RetCam wide-field infant fundus image — 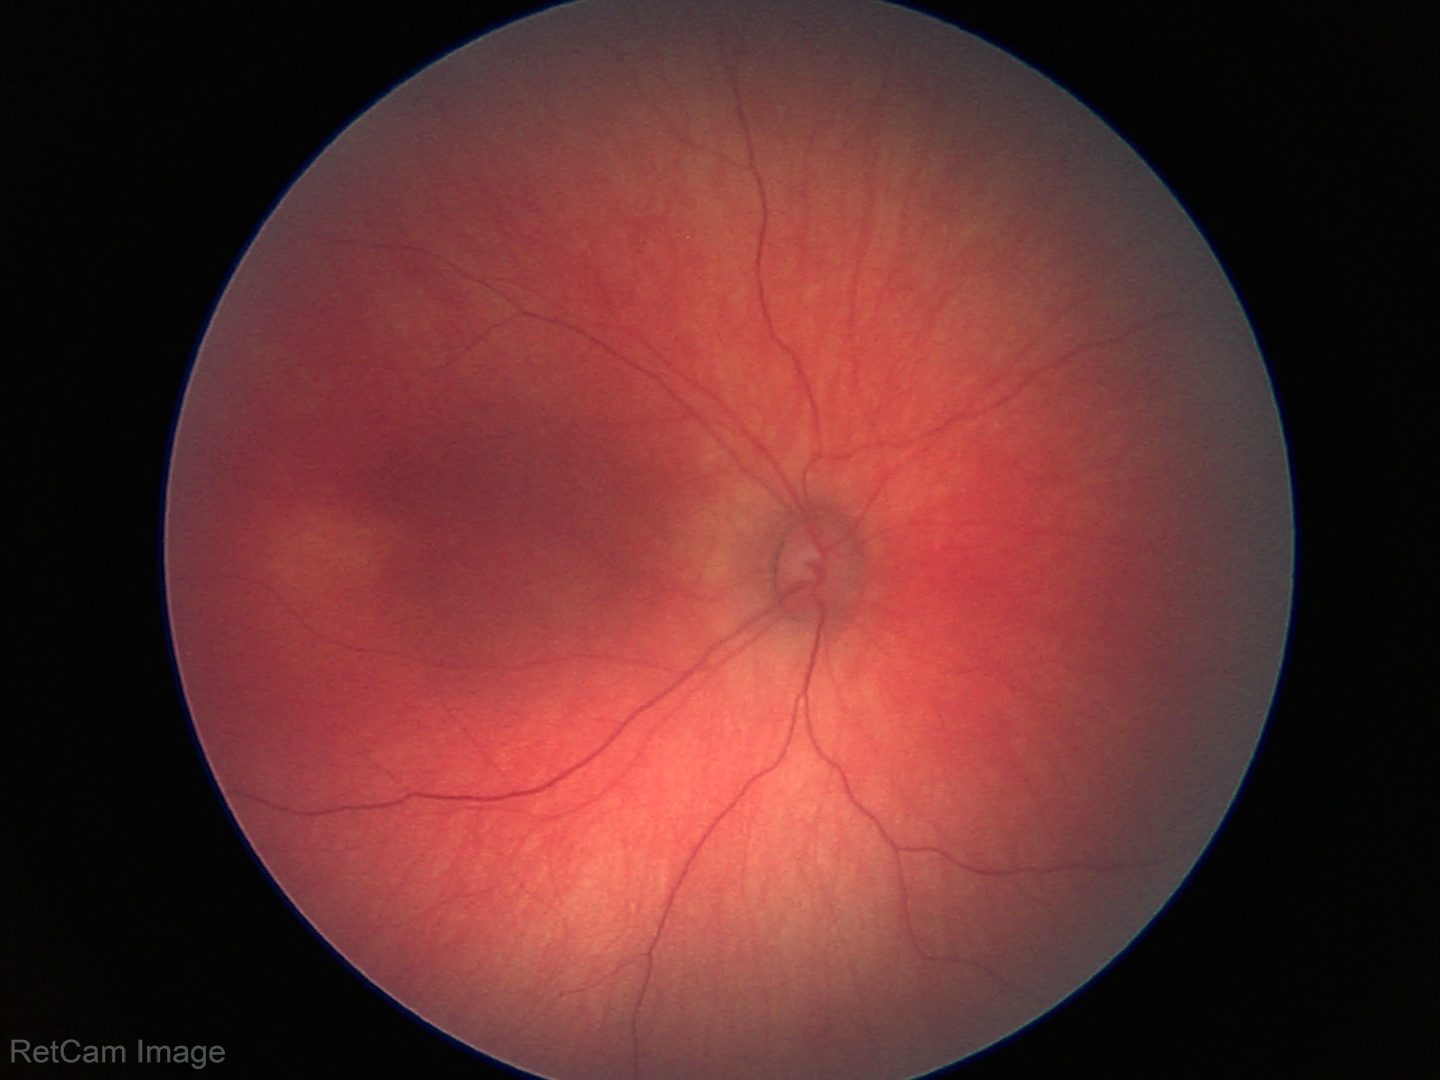
Normal screening examination.